2352x1568: 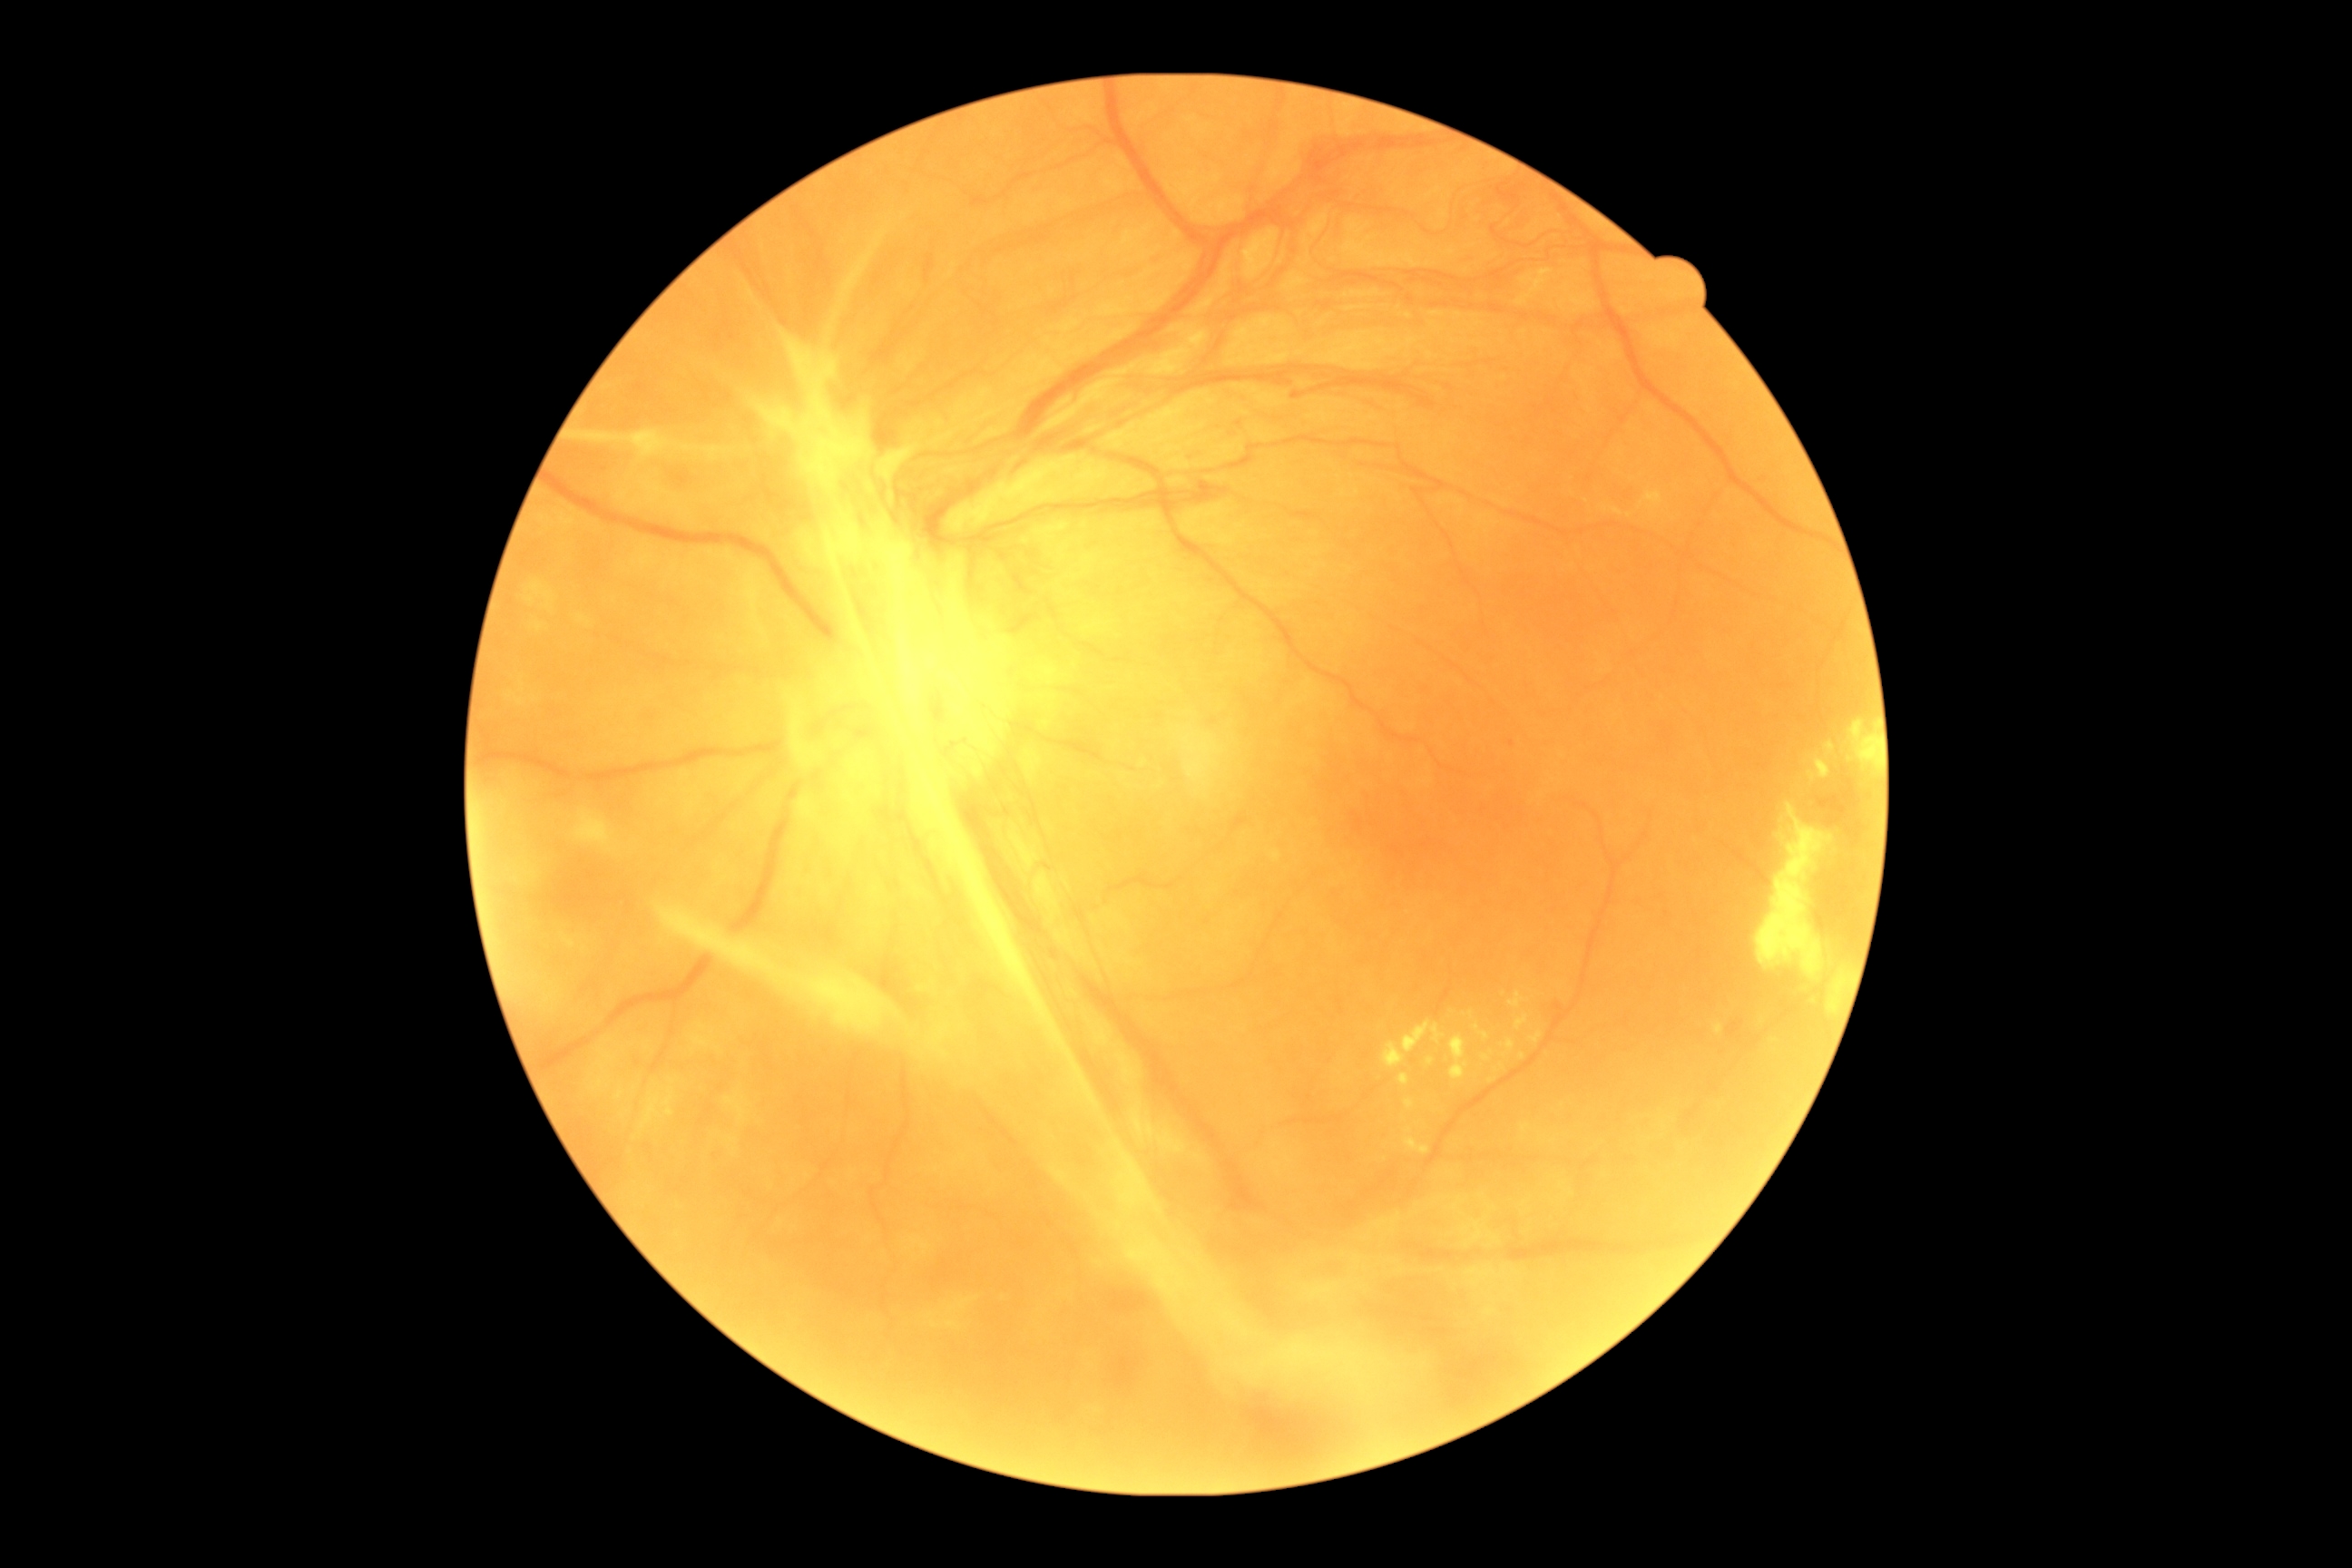

Diabetic retinopathy severity: grade 4.